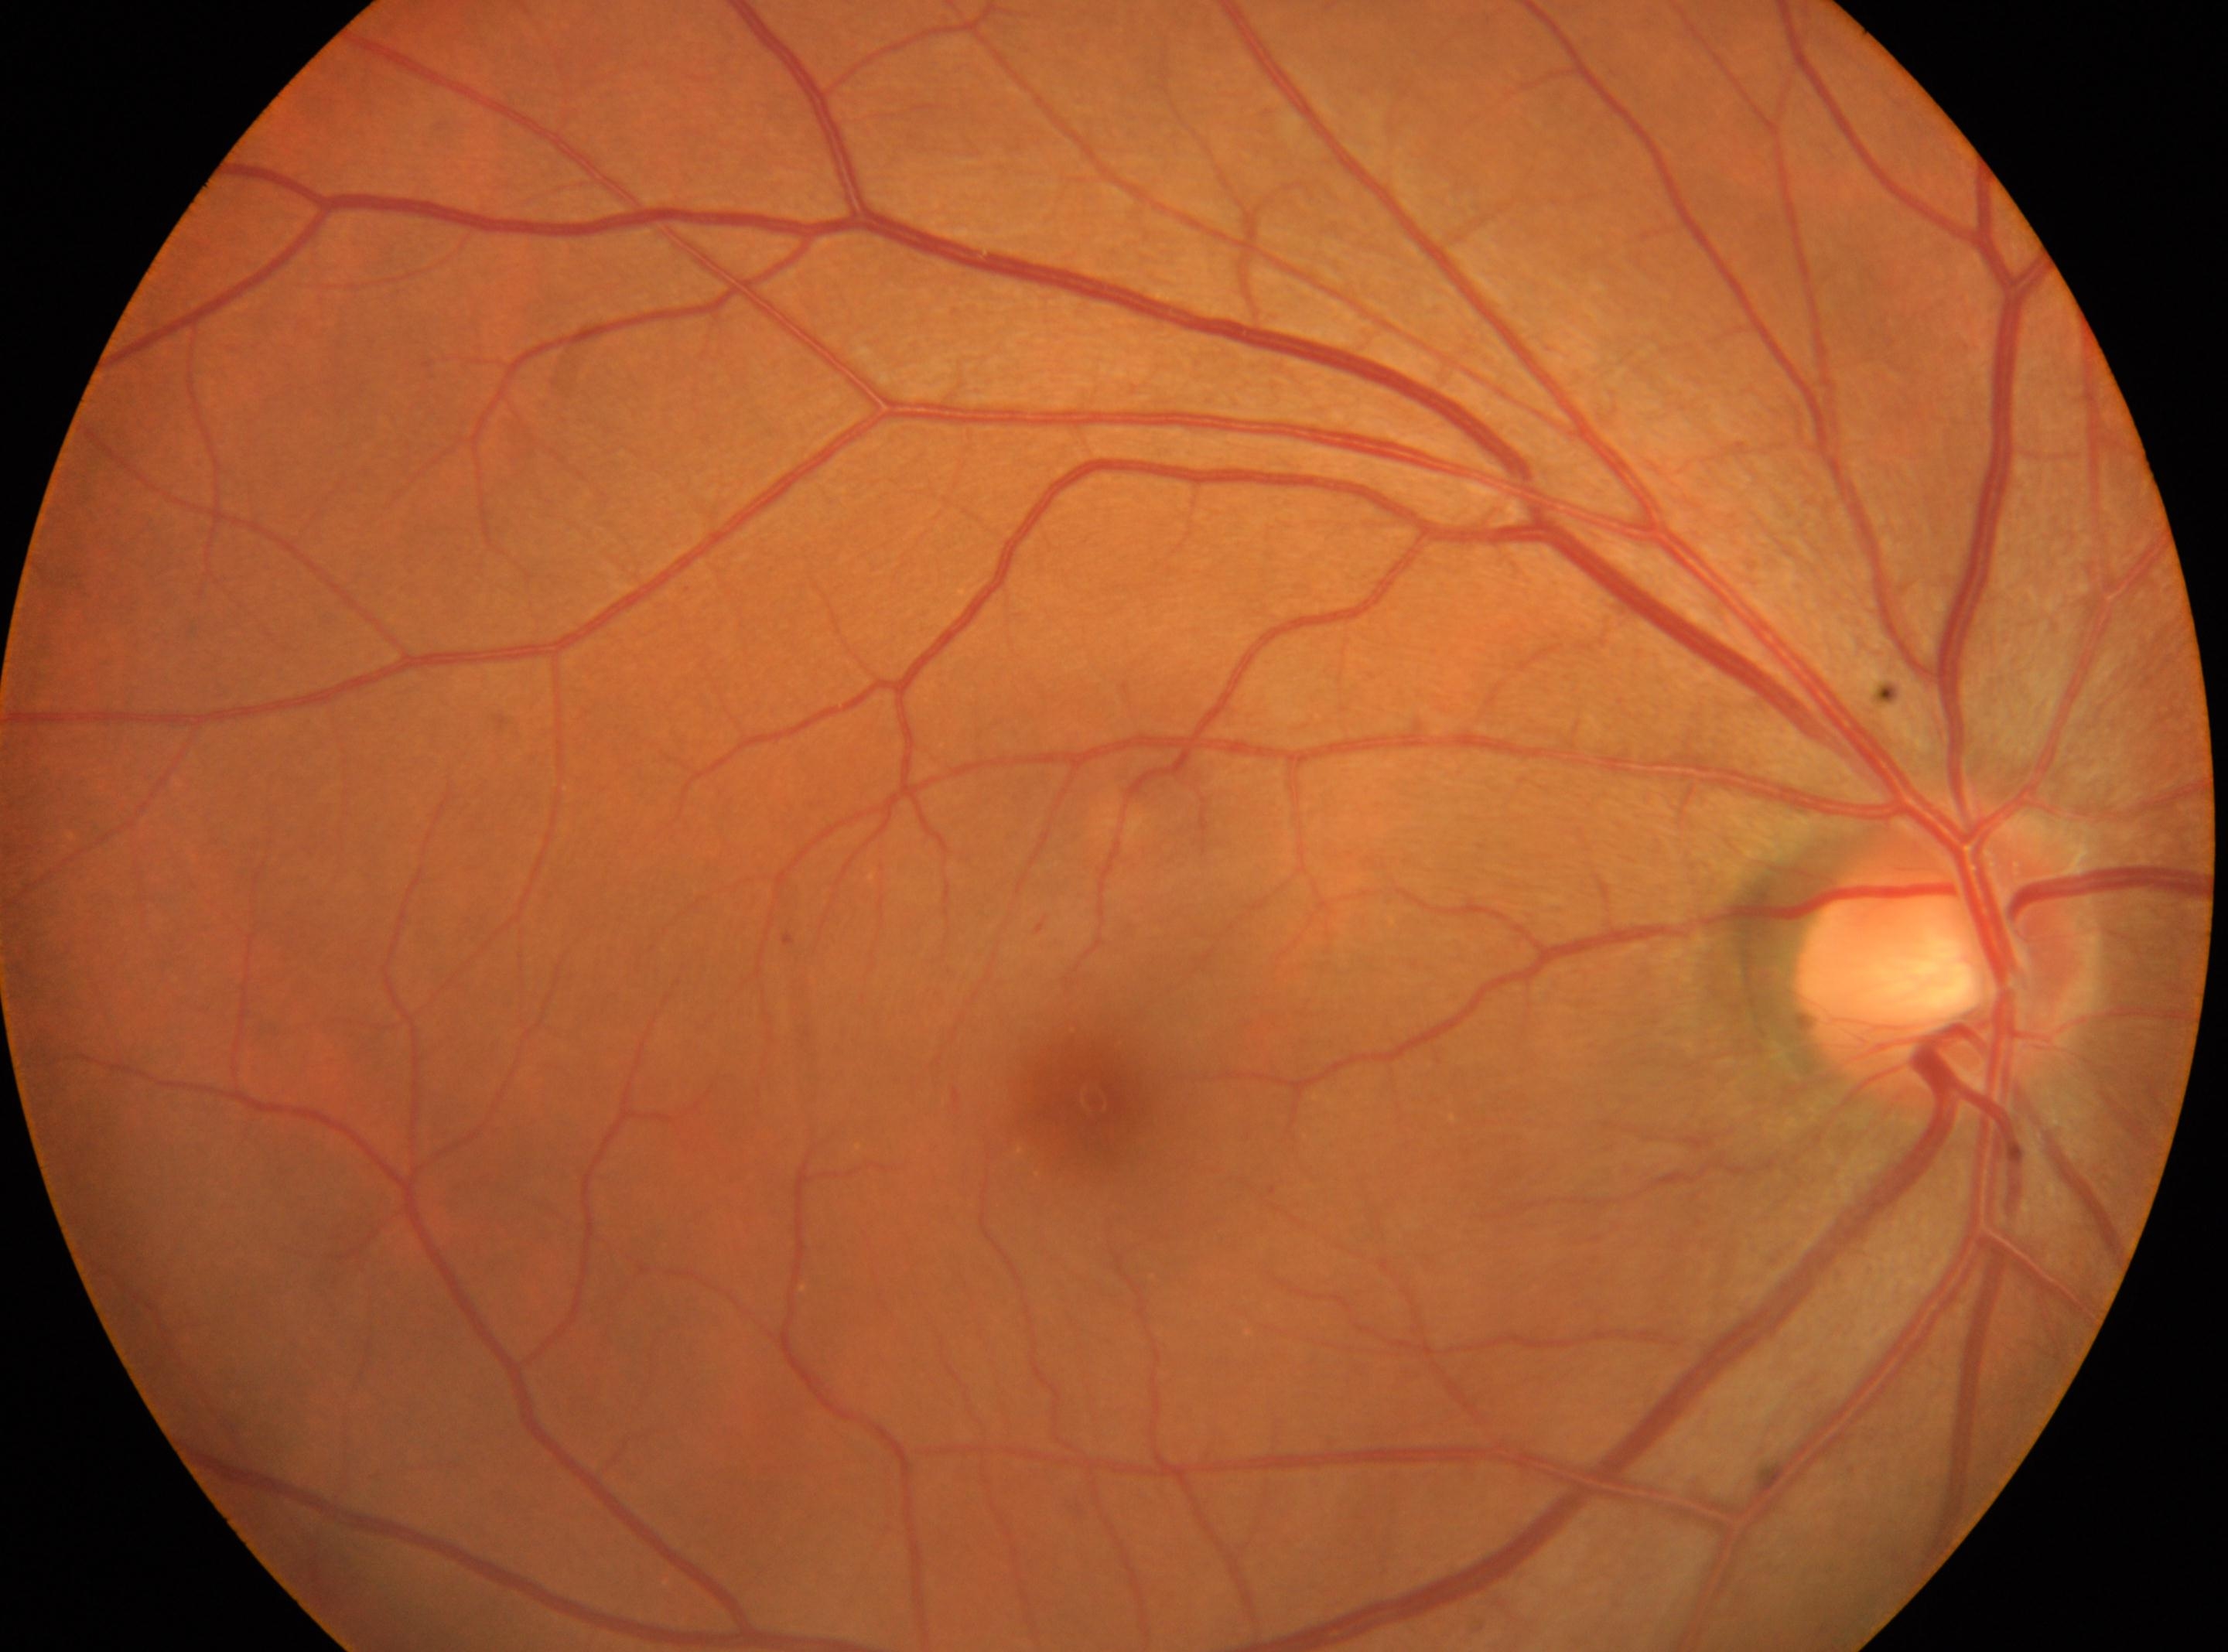

the fovea: (1091,1100)
retinopathy grade: mild NPDR (1)
the optic disc: (1939,954)
laterality: oculus dexter